Optic disc-centered crop, non-mydriatic fundus camera — 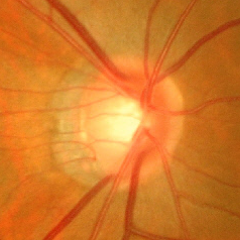

Glaucomatous optic neuropathy is present. Fundus image with findings of advanced glaucomatous optic neuropathy.